Wide-field contact fundus photograph of an infant.
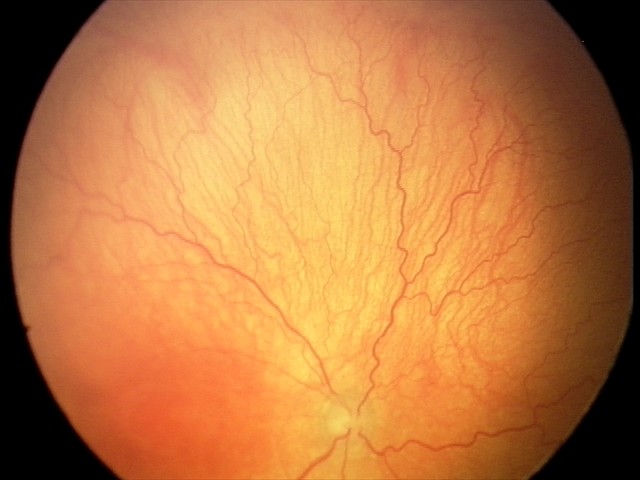
Plus disease was diagnosed. Diagnosis from this screening exam: aggressive ROP (A-ROP).